45° field of view, 2352 x 1568 pixels, retinal fundus photograph.
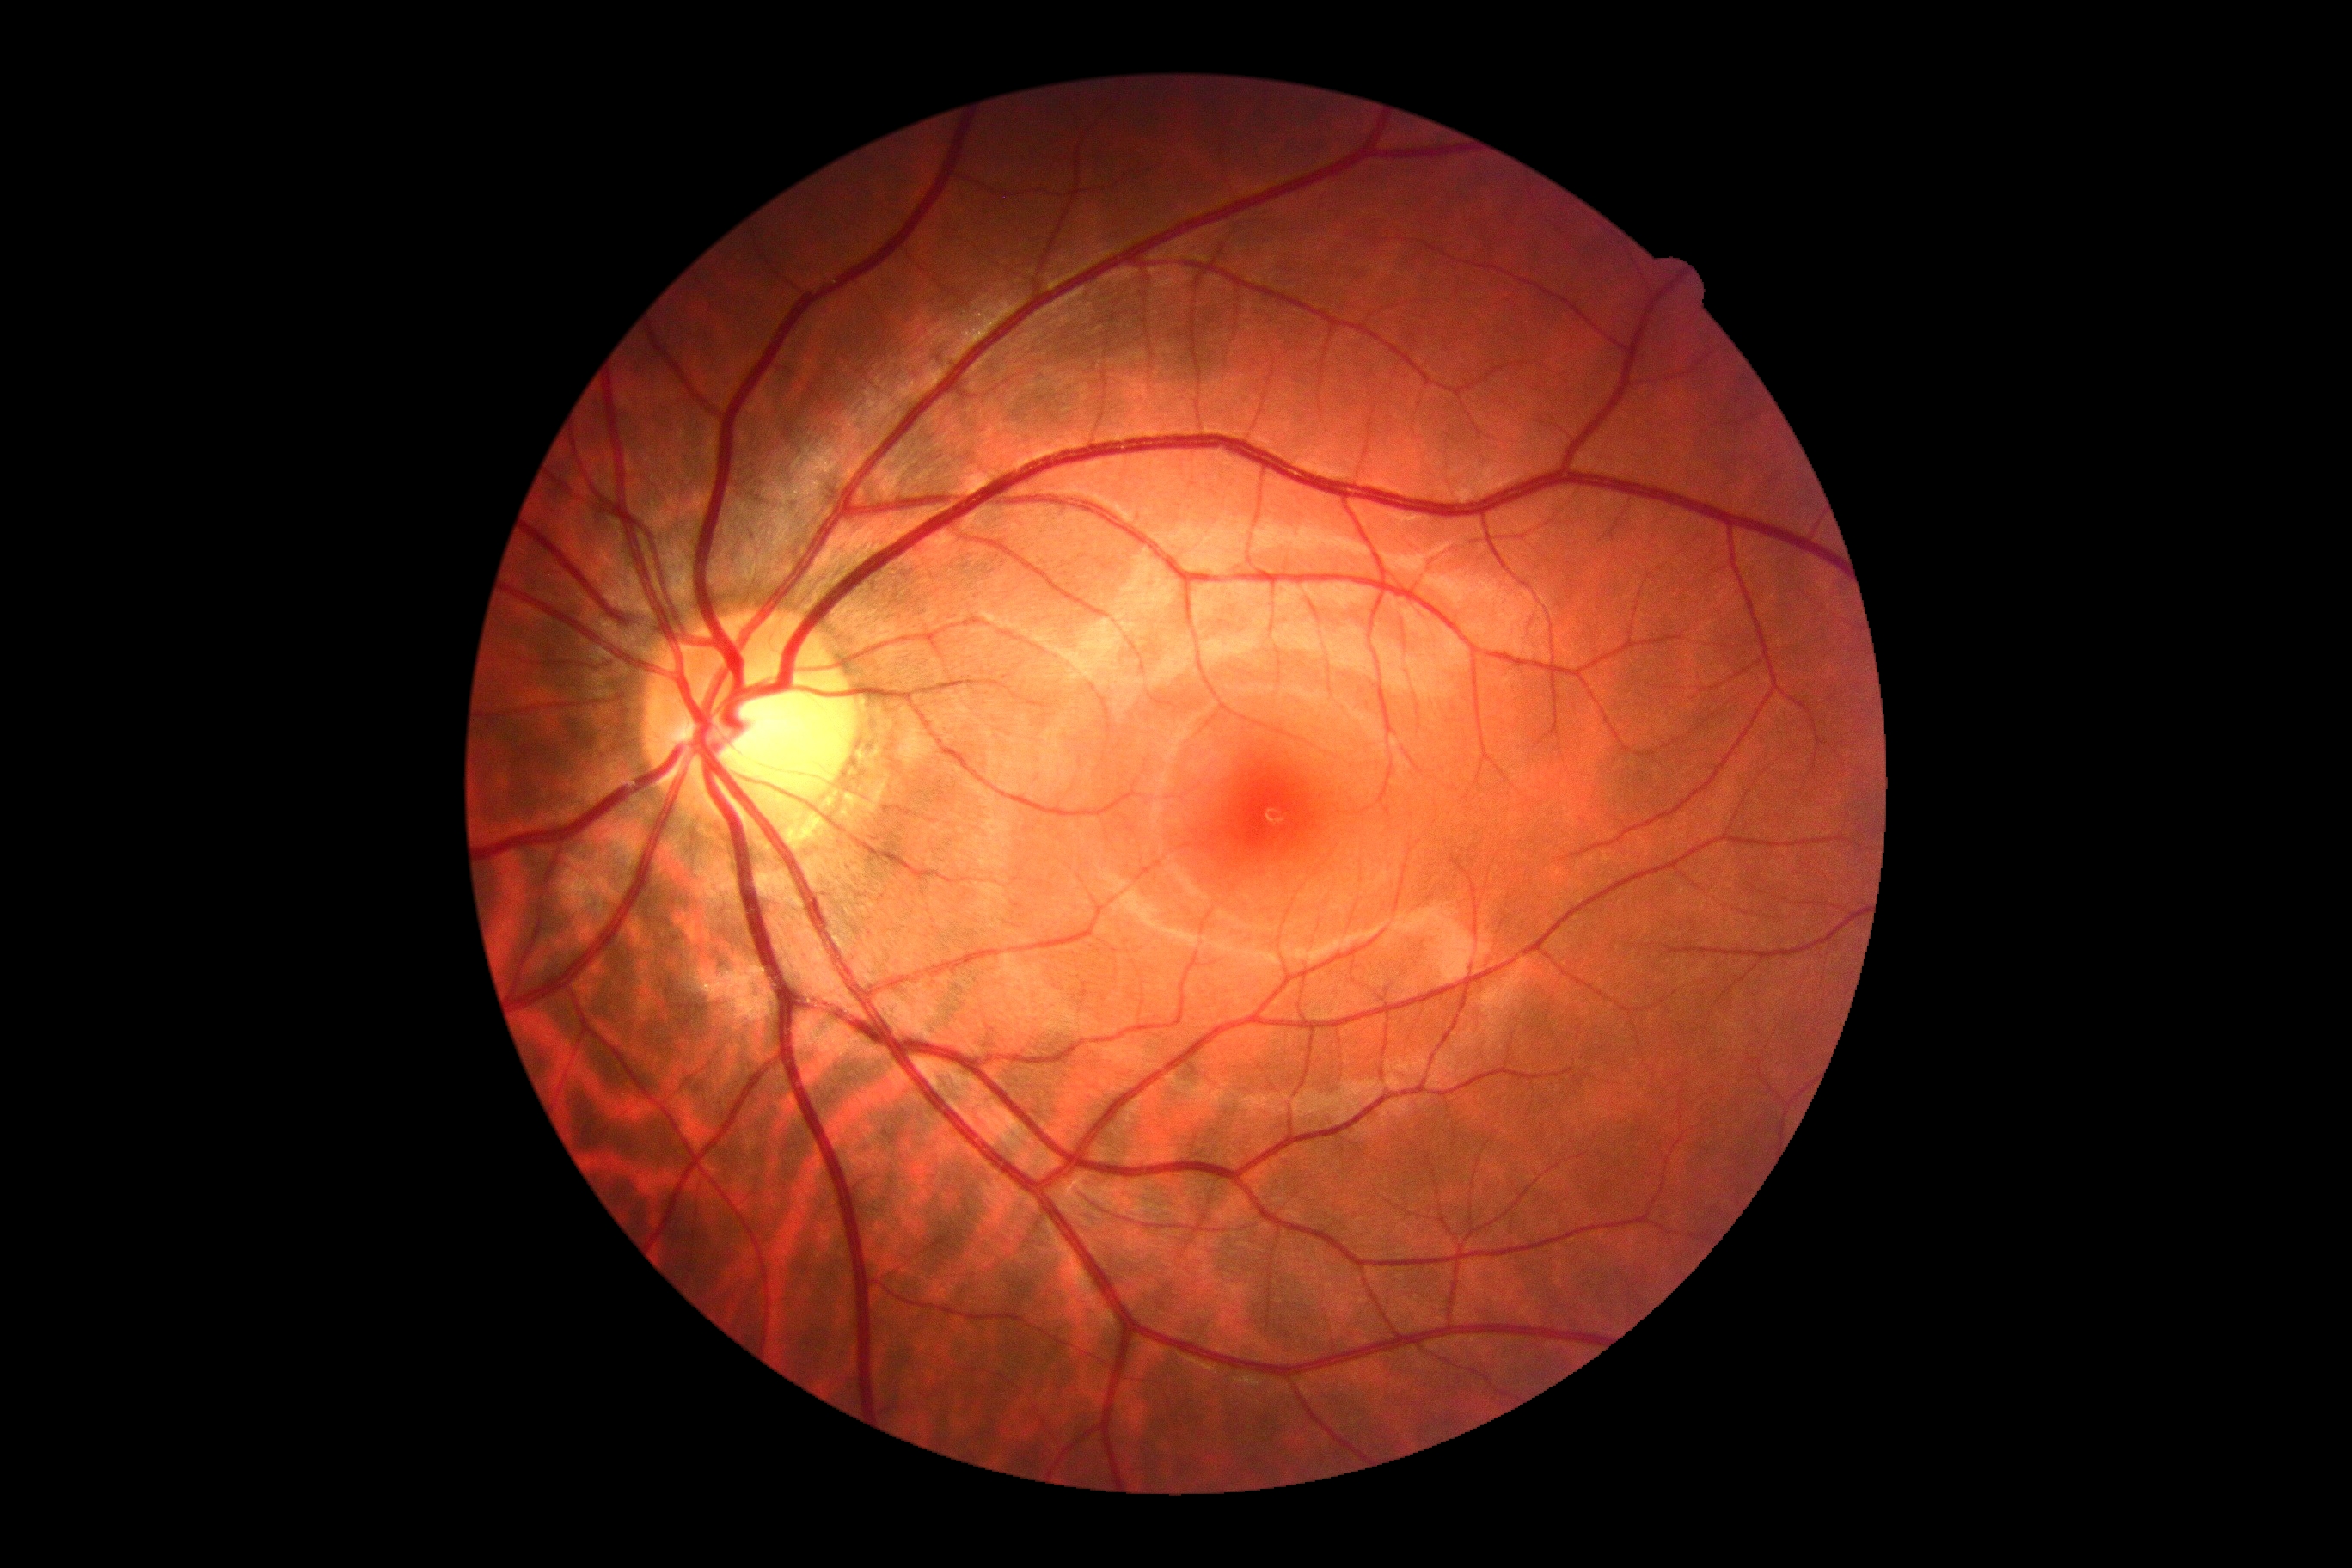

dr_impression: negative for DR
dr_grade: no apparent diabetic retinopathy (grade 0)